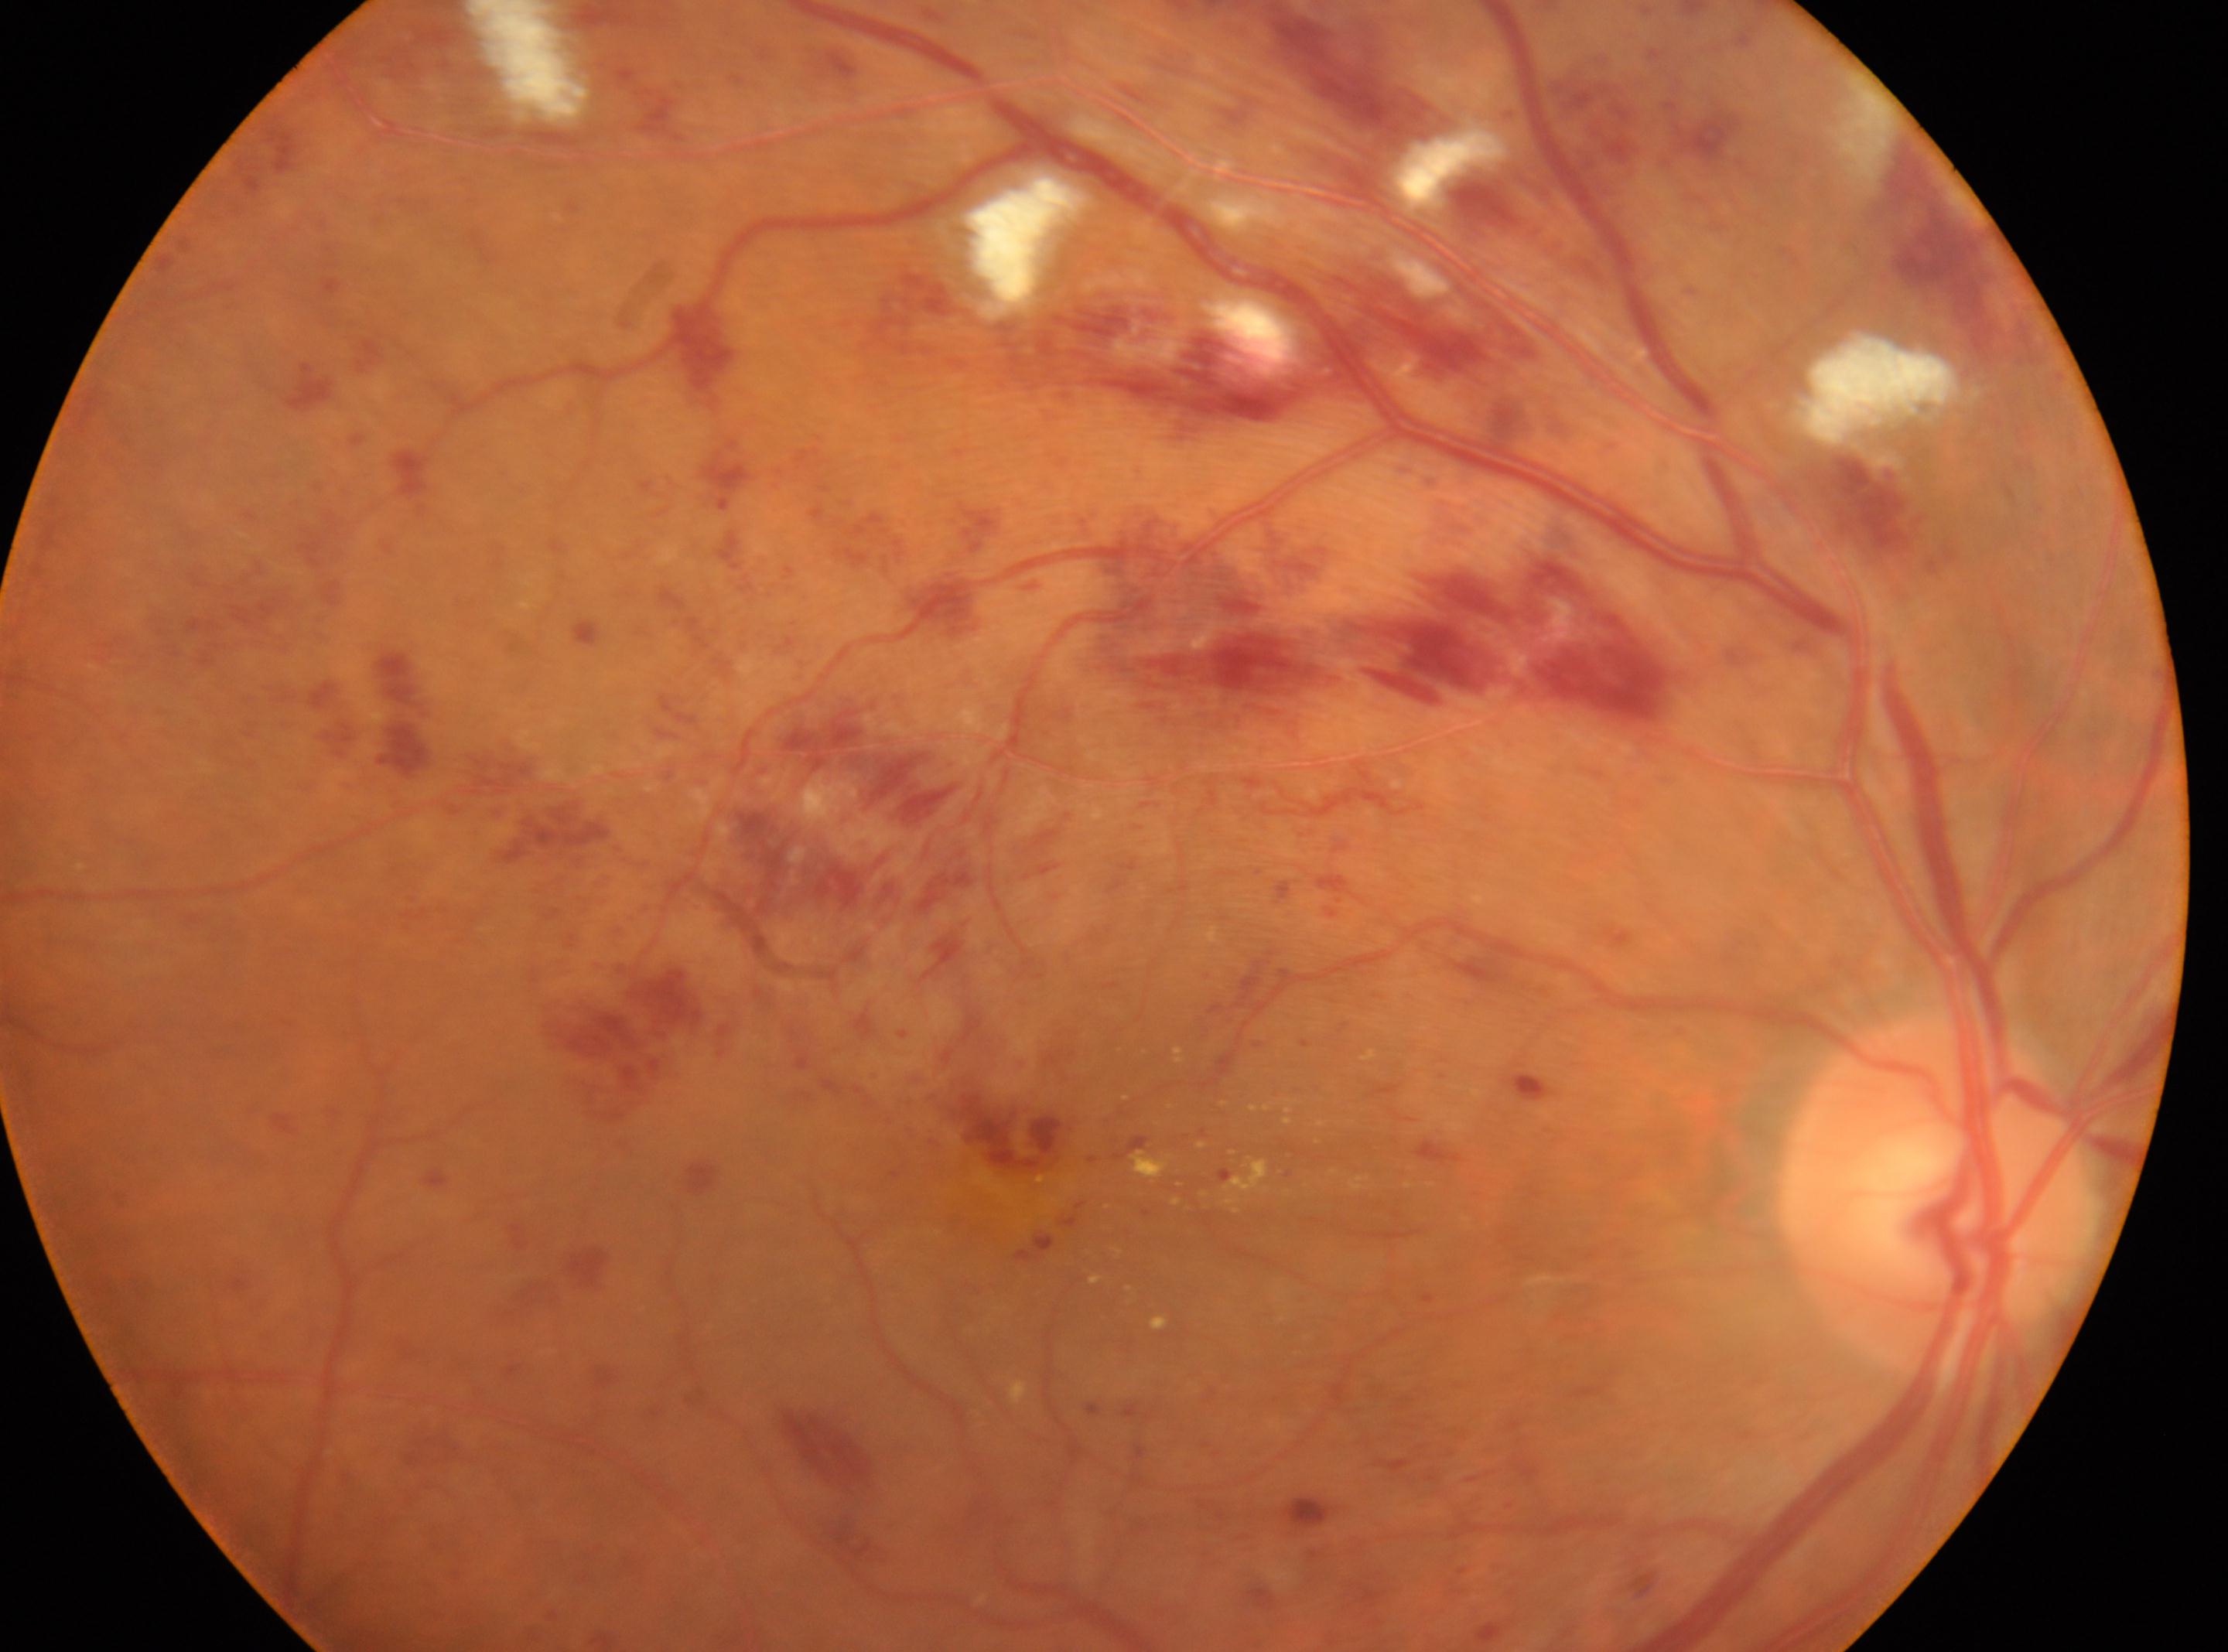 The macular center is at (1040,1160). Optic disc: (1936,1196). Disease class: non-proliferative diabetic retinopathy. DR severity: 3/4. Eye: right.